640x480px · infant wide-field retinal image:
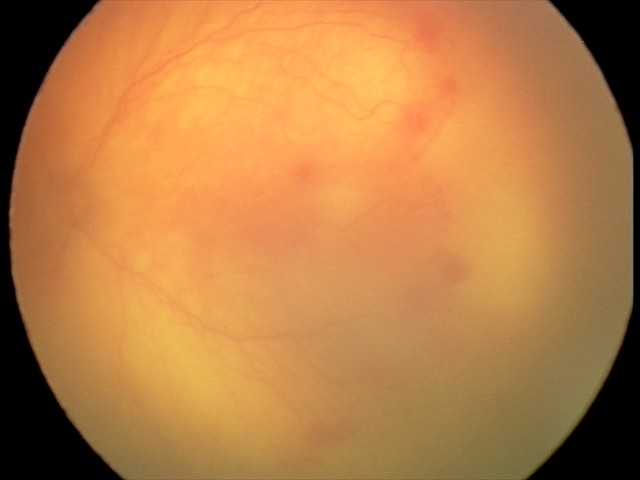 Series diagnosed as aggressive ROP (A-ROP).
With plus disease.